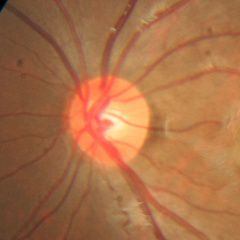

Q: Does this eye have glaucoma?
A: No glaucoma.